Infant wide-field fundus photograph: 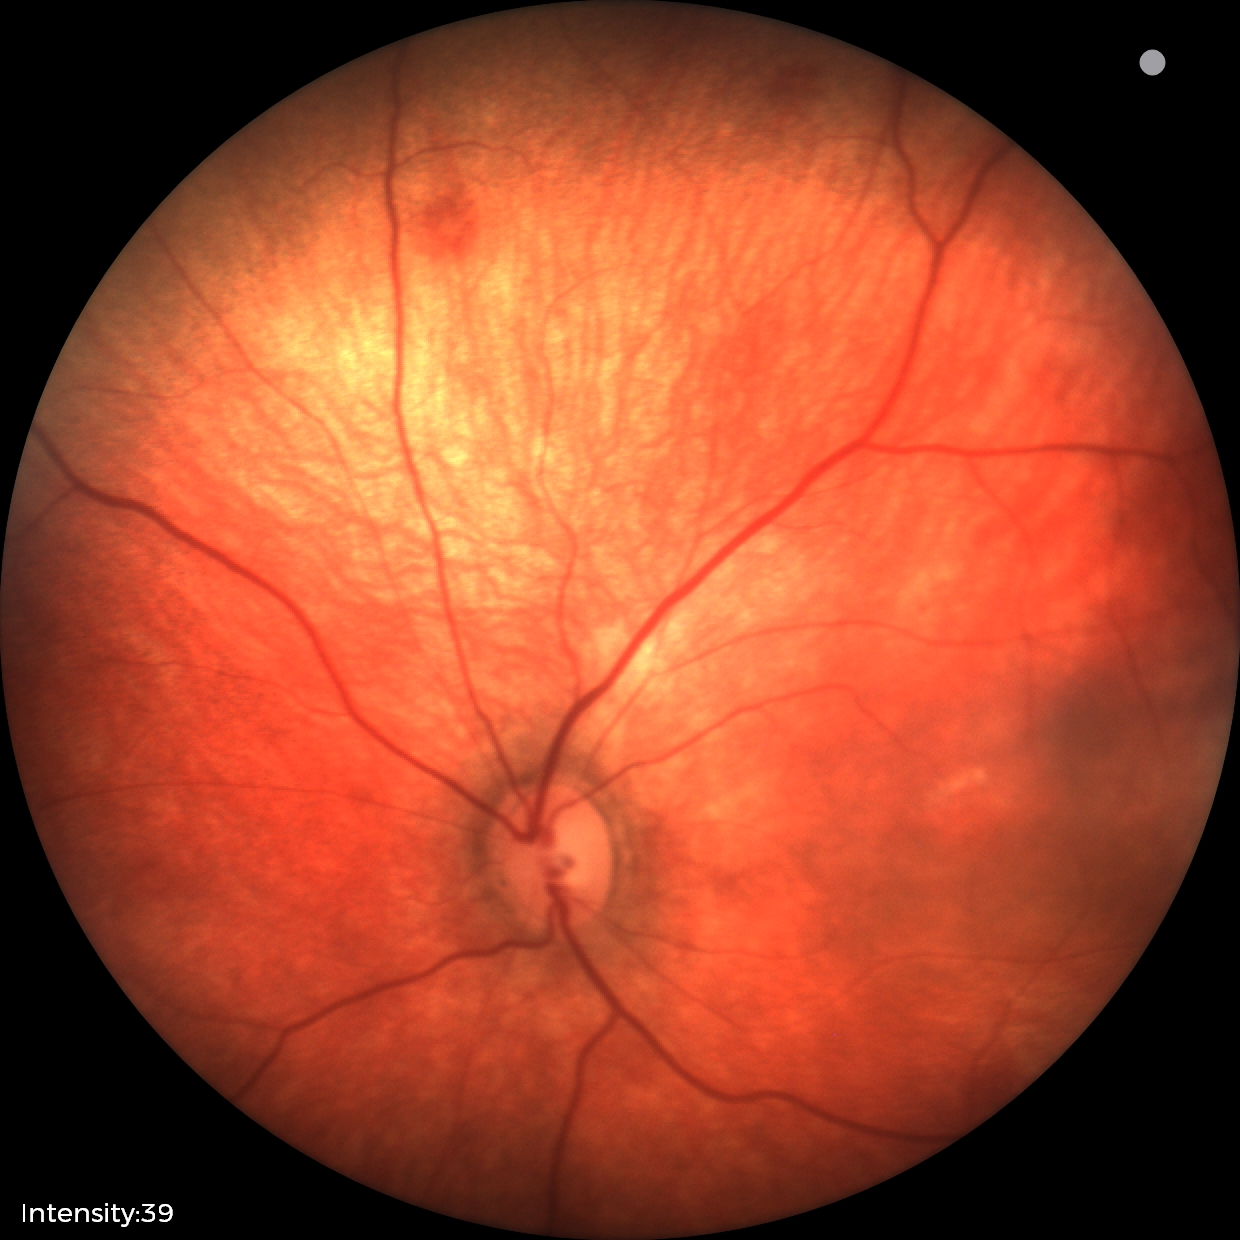 Finding: retinal hemorrhages.